Camera: Clarity RetCam 3 (130° FOV) · pediatric wide-field fundus photograph:
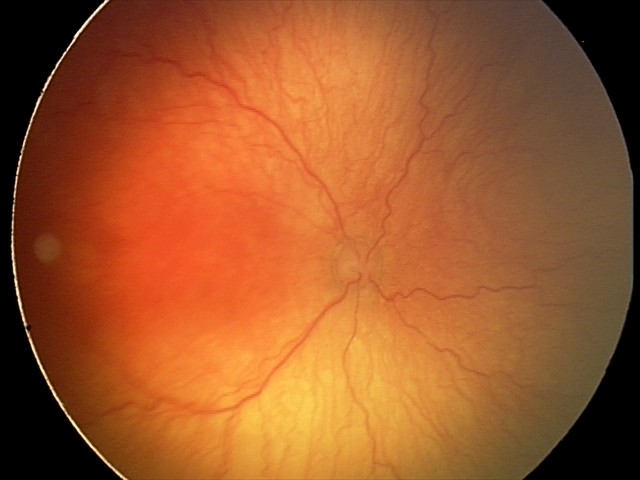 With plus disease.
From an examination with diagnosis of aggressive ROP (A-ROP).